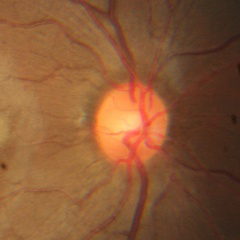

Optic disc photograph demonstrating no glaucomatous optic neuropathy.